45° FOV, color fundus image, image size 2212x1659: 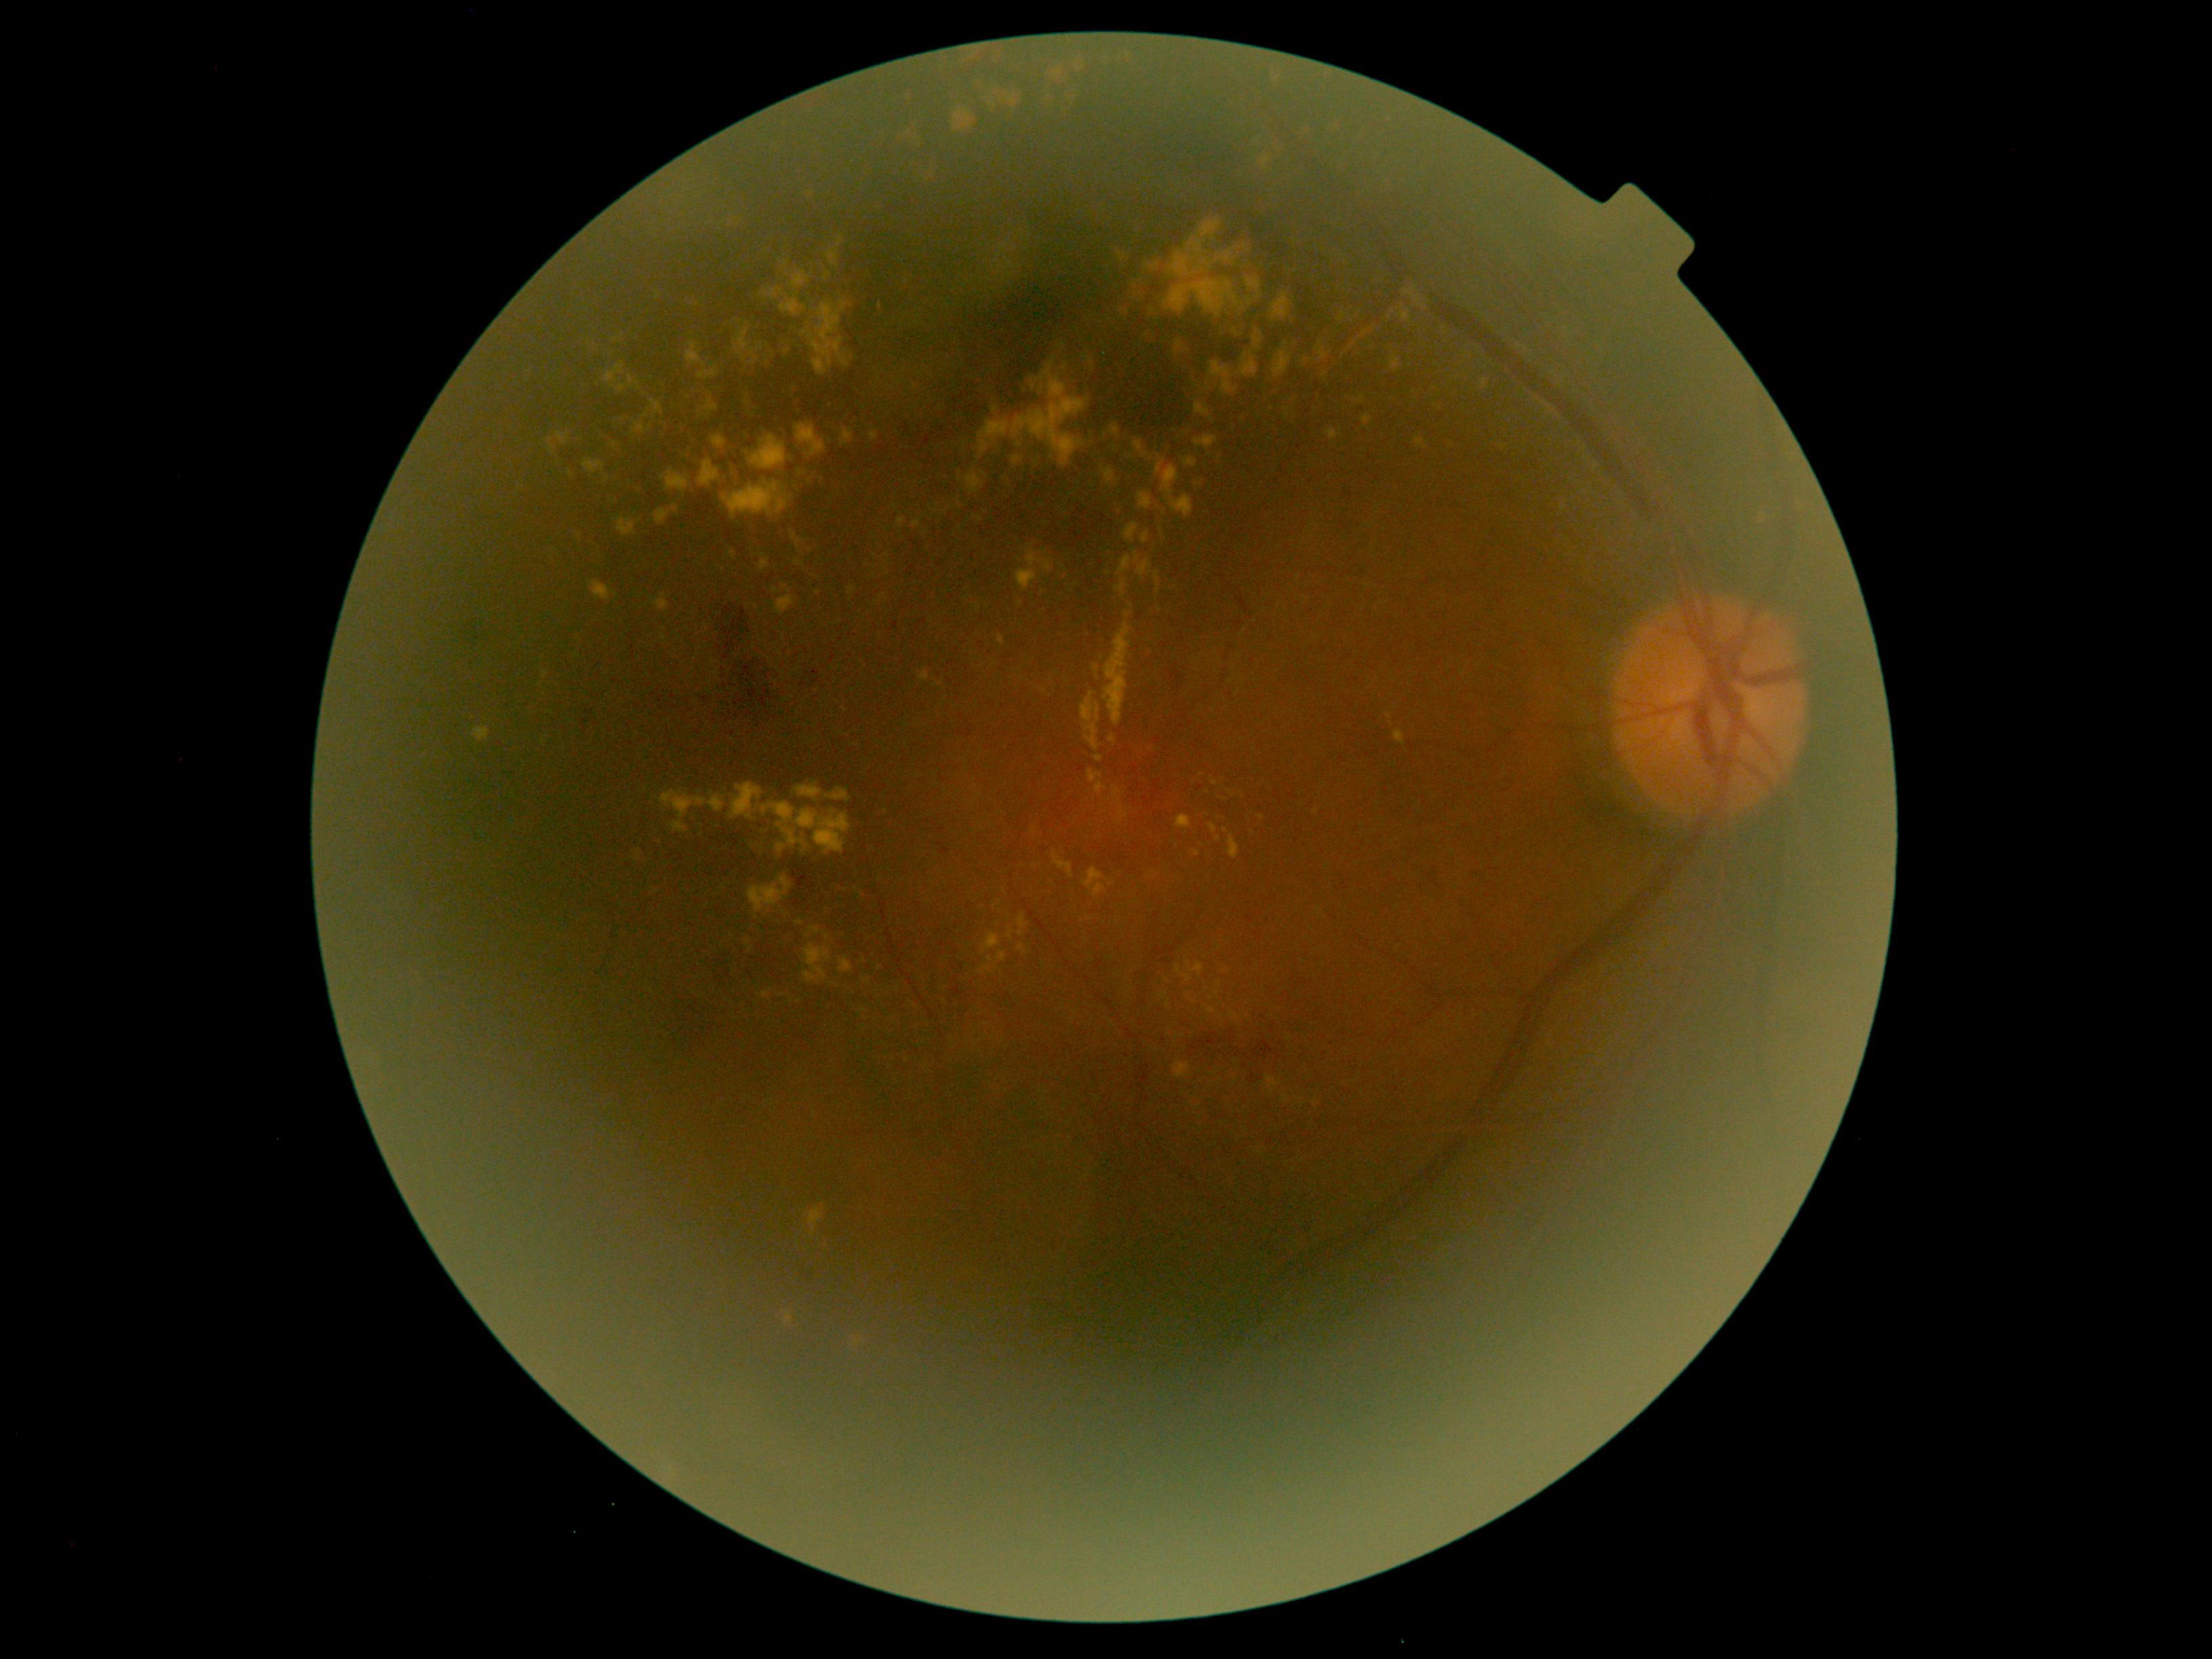

DR grade is 2
A subset of detected lesions:
- EXs (more not shown): x1=1118, y1=798, x2=1128, y2=826; x1=1105, y1=468, x2=1116, y2=486; x1=1040, y1=386, x2=1044, y2=394; x1=722, y1=479, x2=794, y2=520; x1=1361, y1=414, x2=1372, y2=426; x1=804, y1=945, x2=832, y2=985; x1=1271, y1=62, x2=1287, y2=94; x1=1119, y1=253, x2=1127, y2=262; x1=617, y1=517, x2=636, y2=537; x1=1094, y1=756, x2=1104, y2=762; x1=655, y1=594, x2=669, y2=612; x1=1019, y1=944, x2=1028, y2=955
- Additional small EXs near (763; 293); (1033; 829); (781; 659); (576; 656); (1065; 367); (659; 295); (1245; 248)